Acquired with a NIDEK AFC-230, without pupil dilation, 848 x 848 pixels, FOV: 45 degrees — 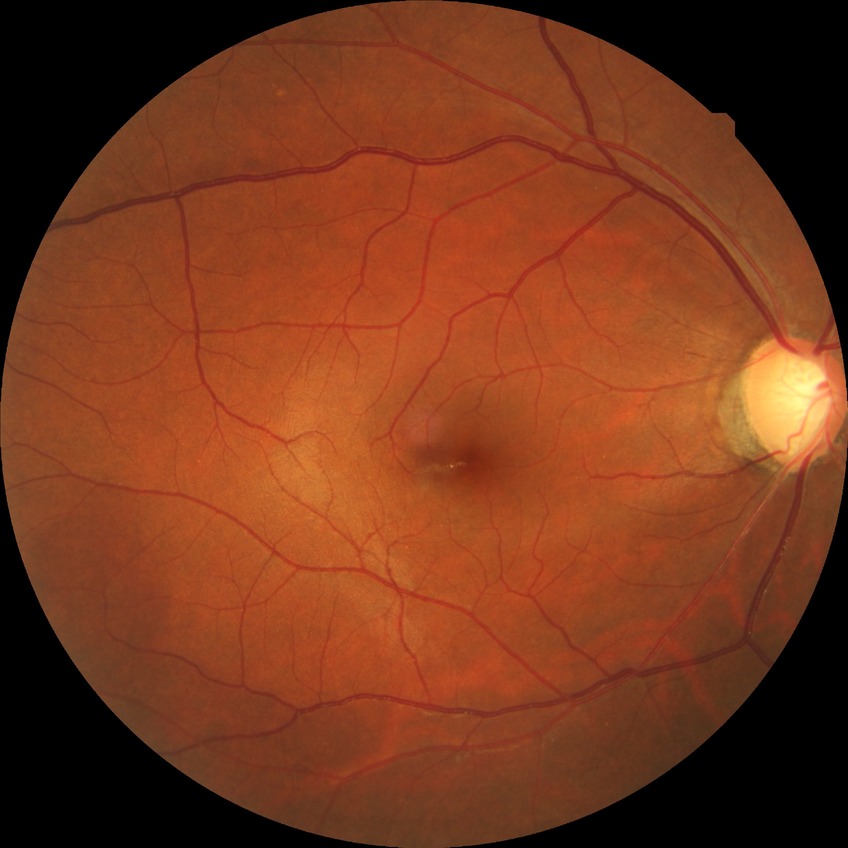

Davis DR grade = NDR.